Retinal fundus photograph:
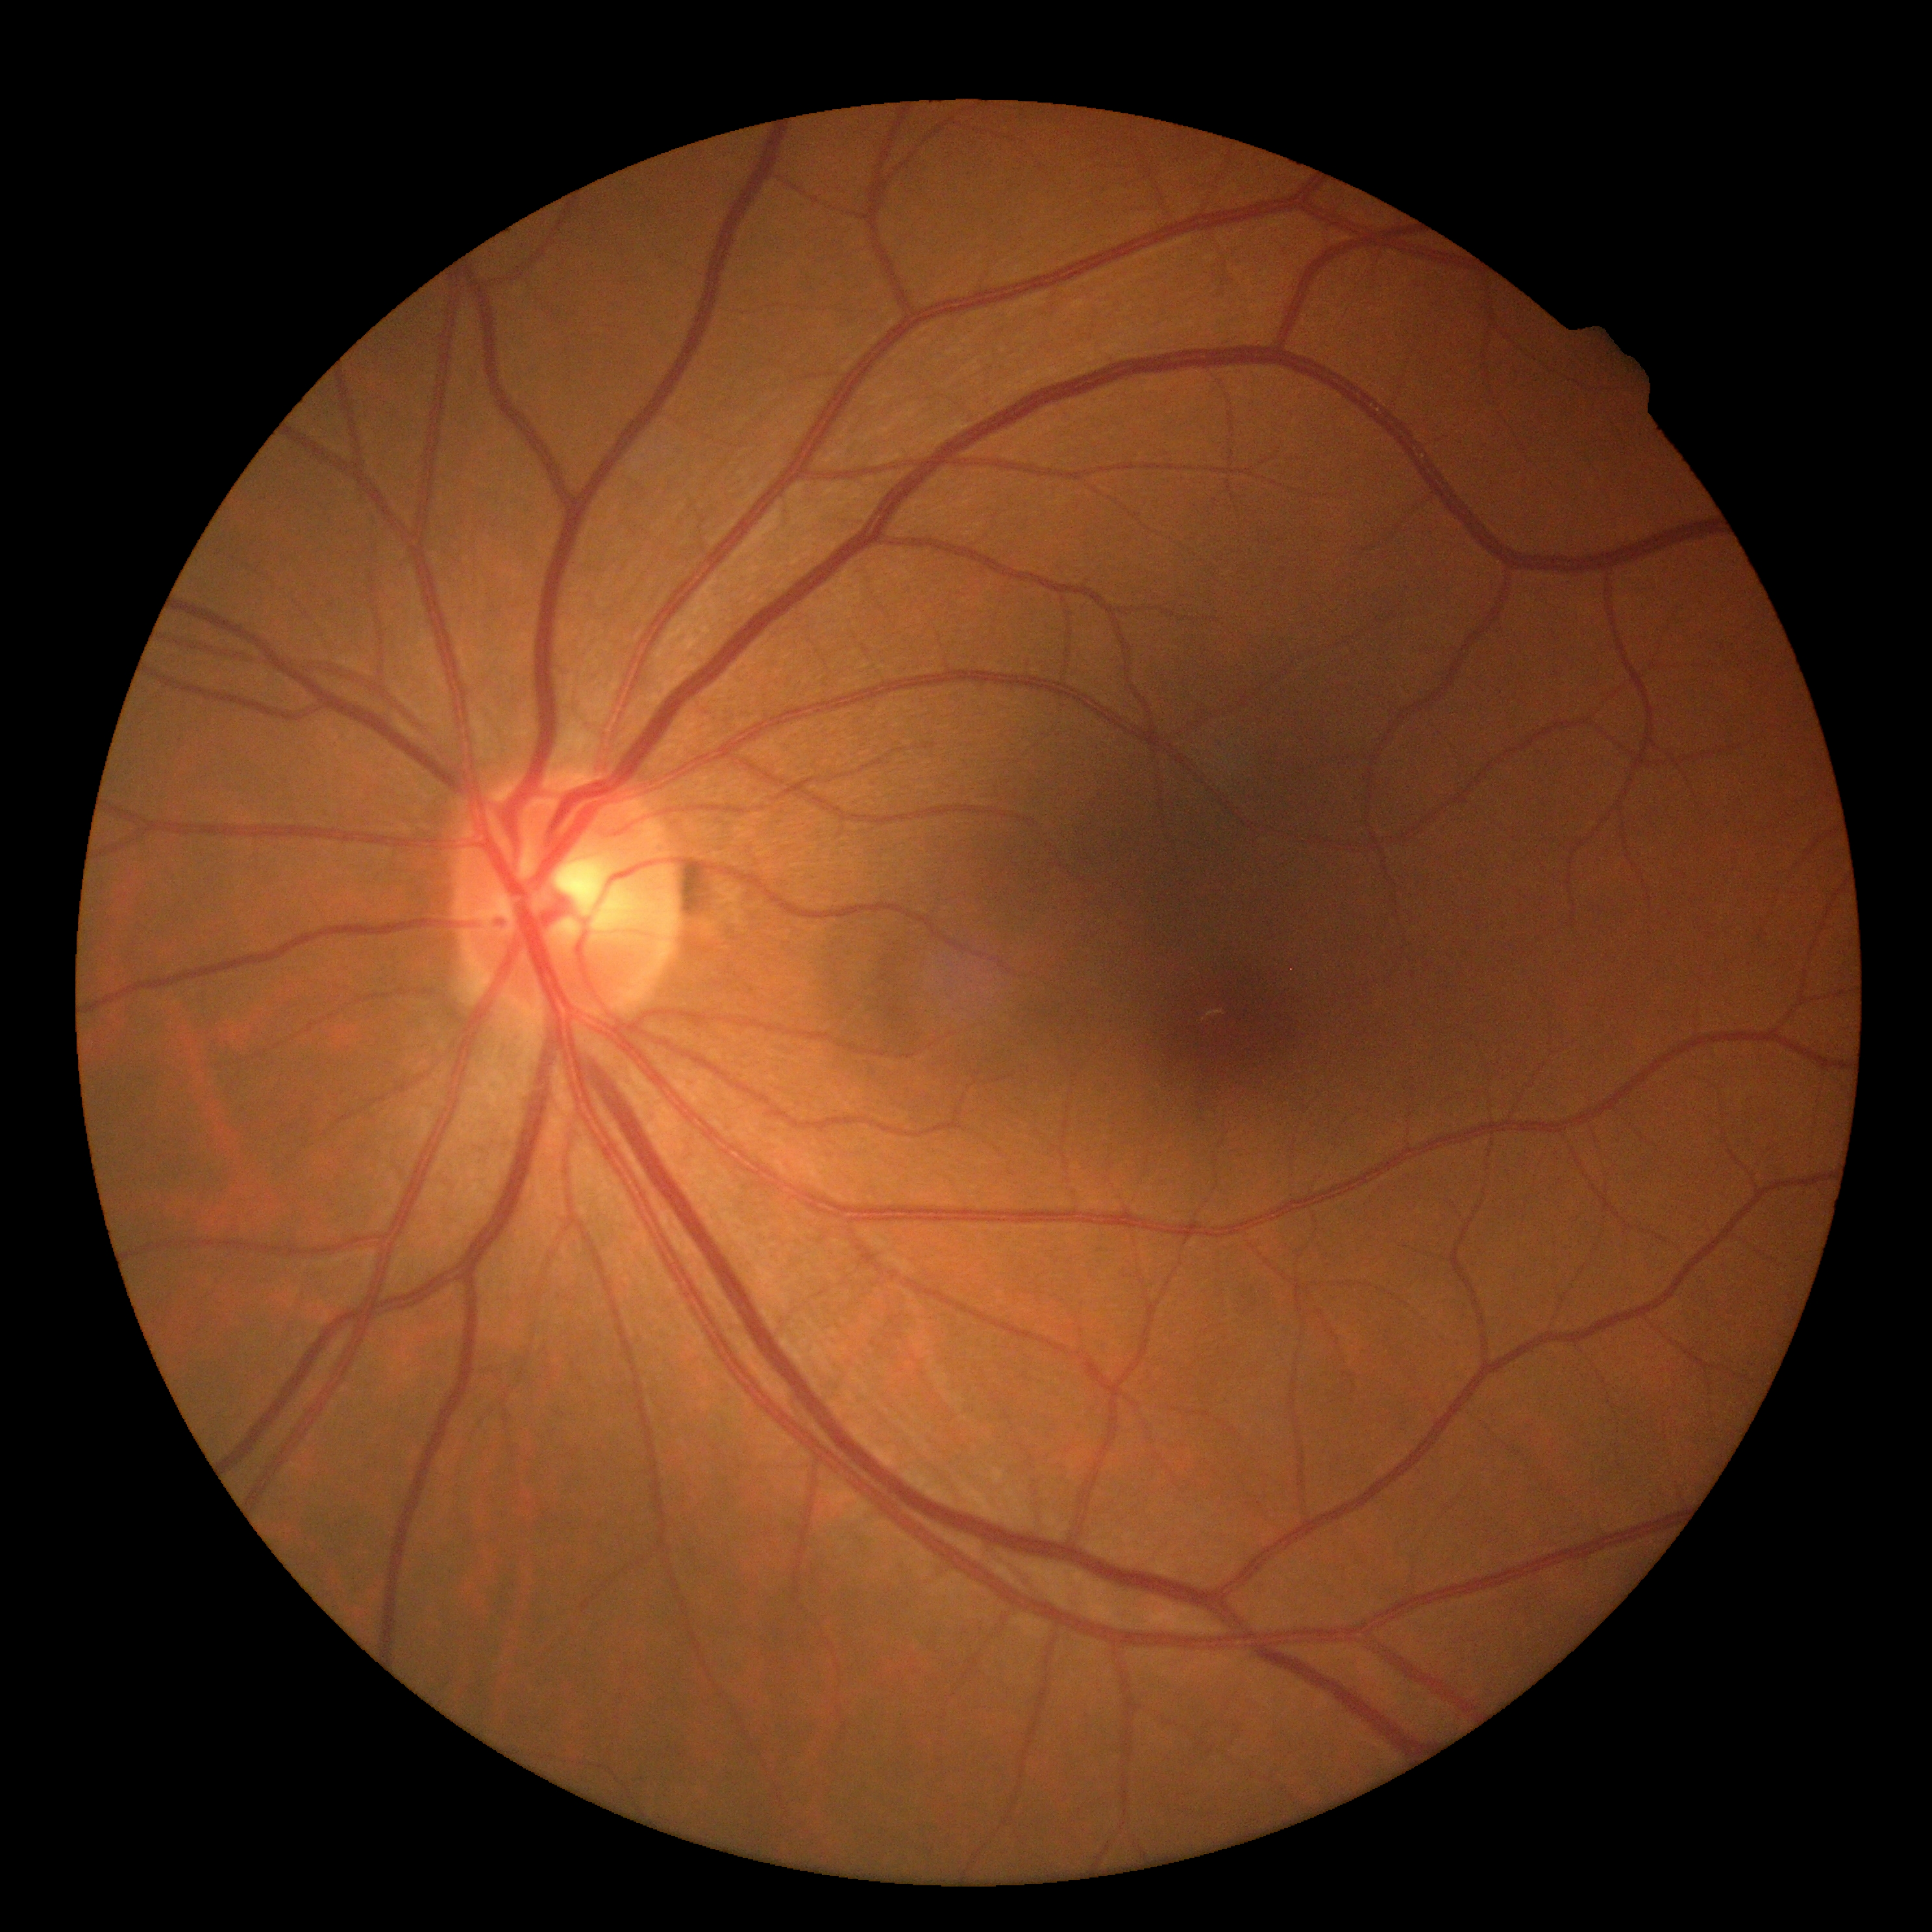 Findings:
– DR stage — no apparent diabetic retinopathy (grade 0)